UWF retinal mosaic — 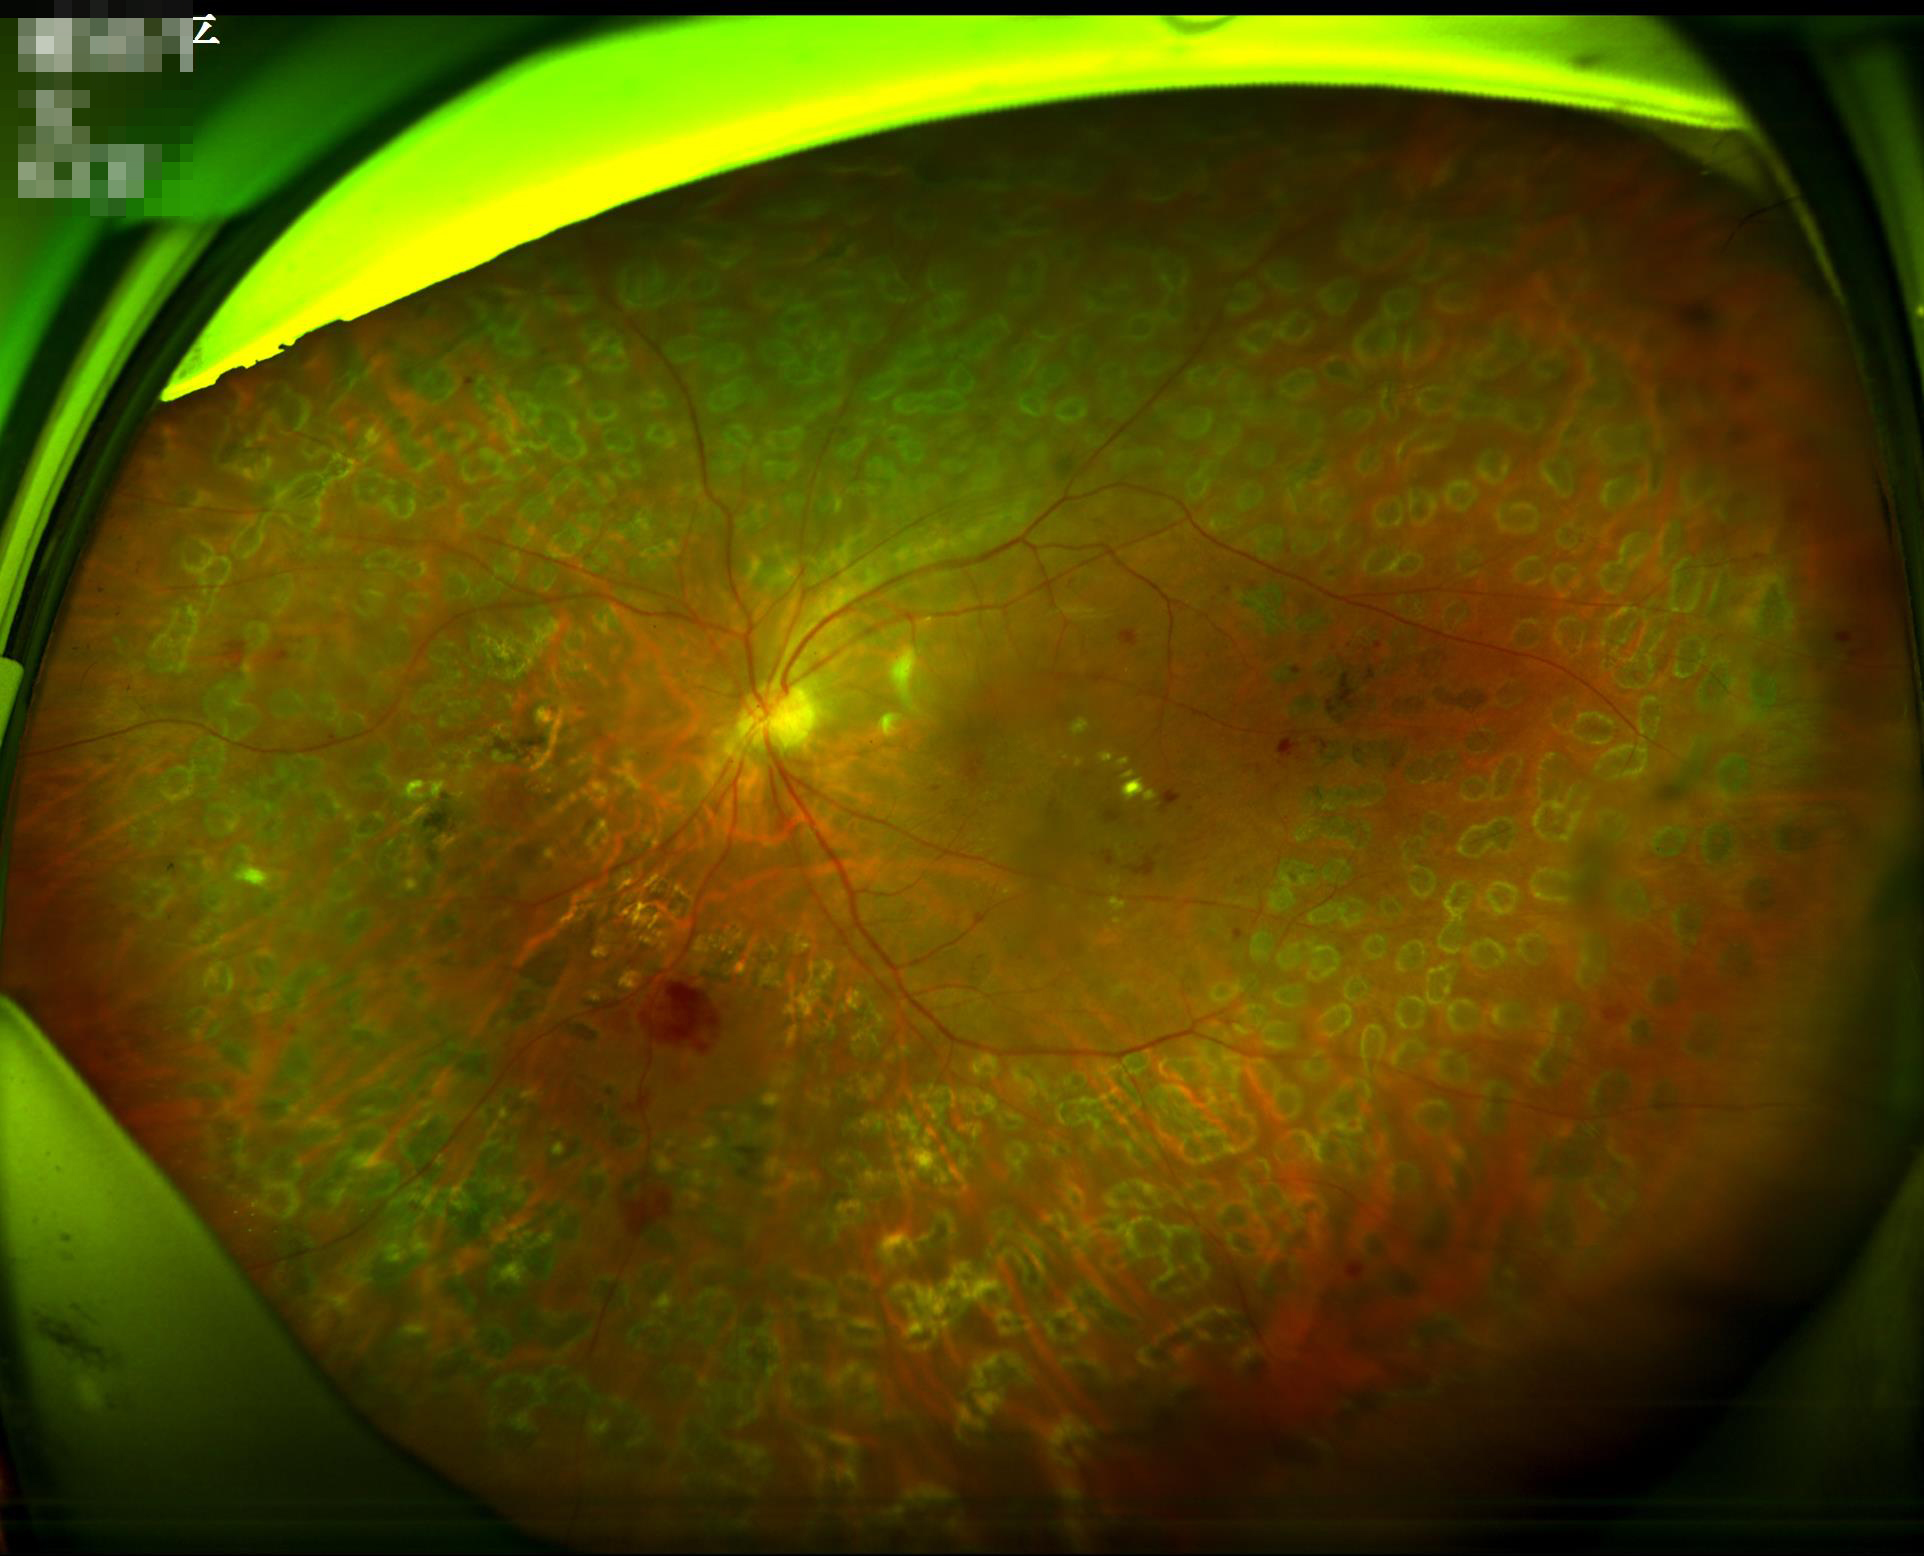 Image quality:
- overall: adequate
- sharpness: in focus
- contrast: adequate
- illumination: even